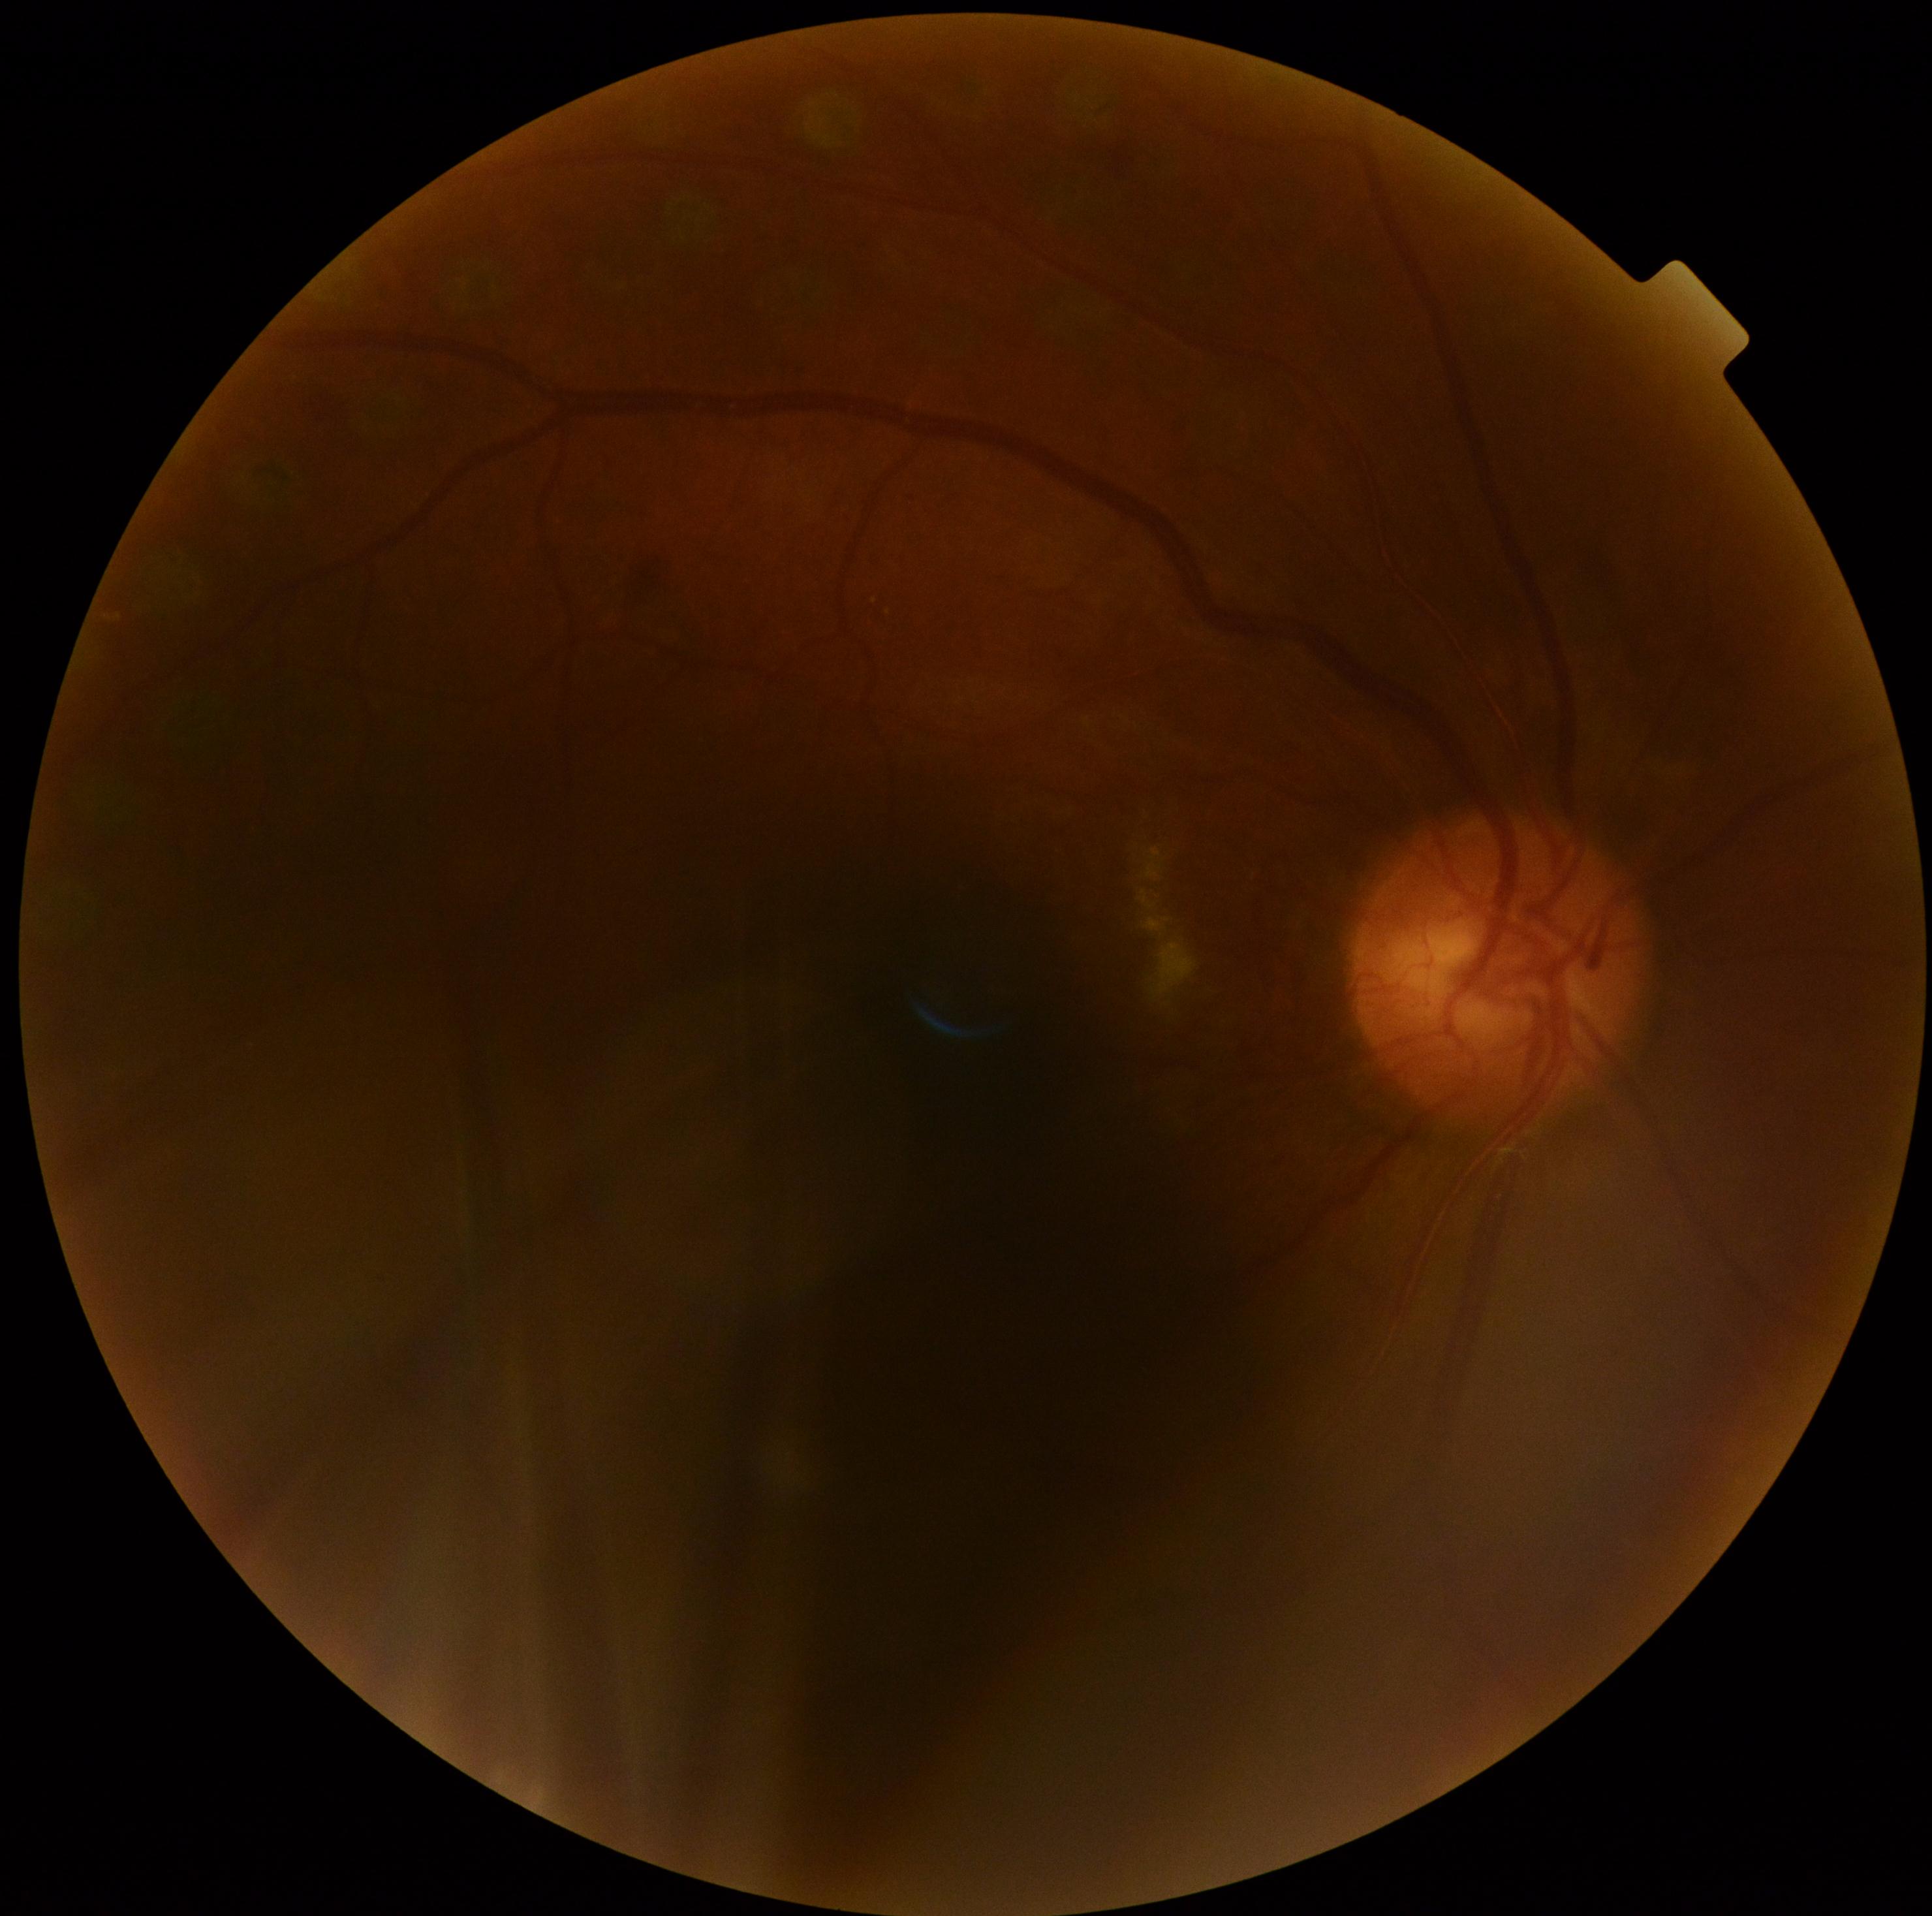
The retinopathy is classified as non-proliferative diabetic retinopathy.
DR grade is 2 (moderate NPDR) — more than just microaneurysms but less than severe NPDR.